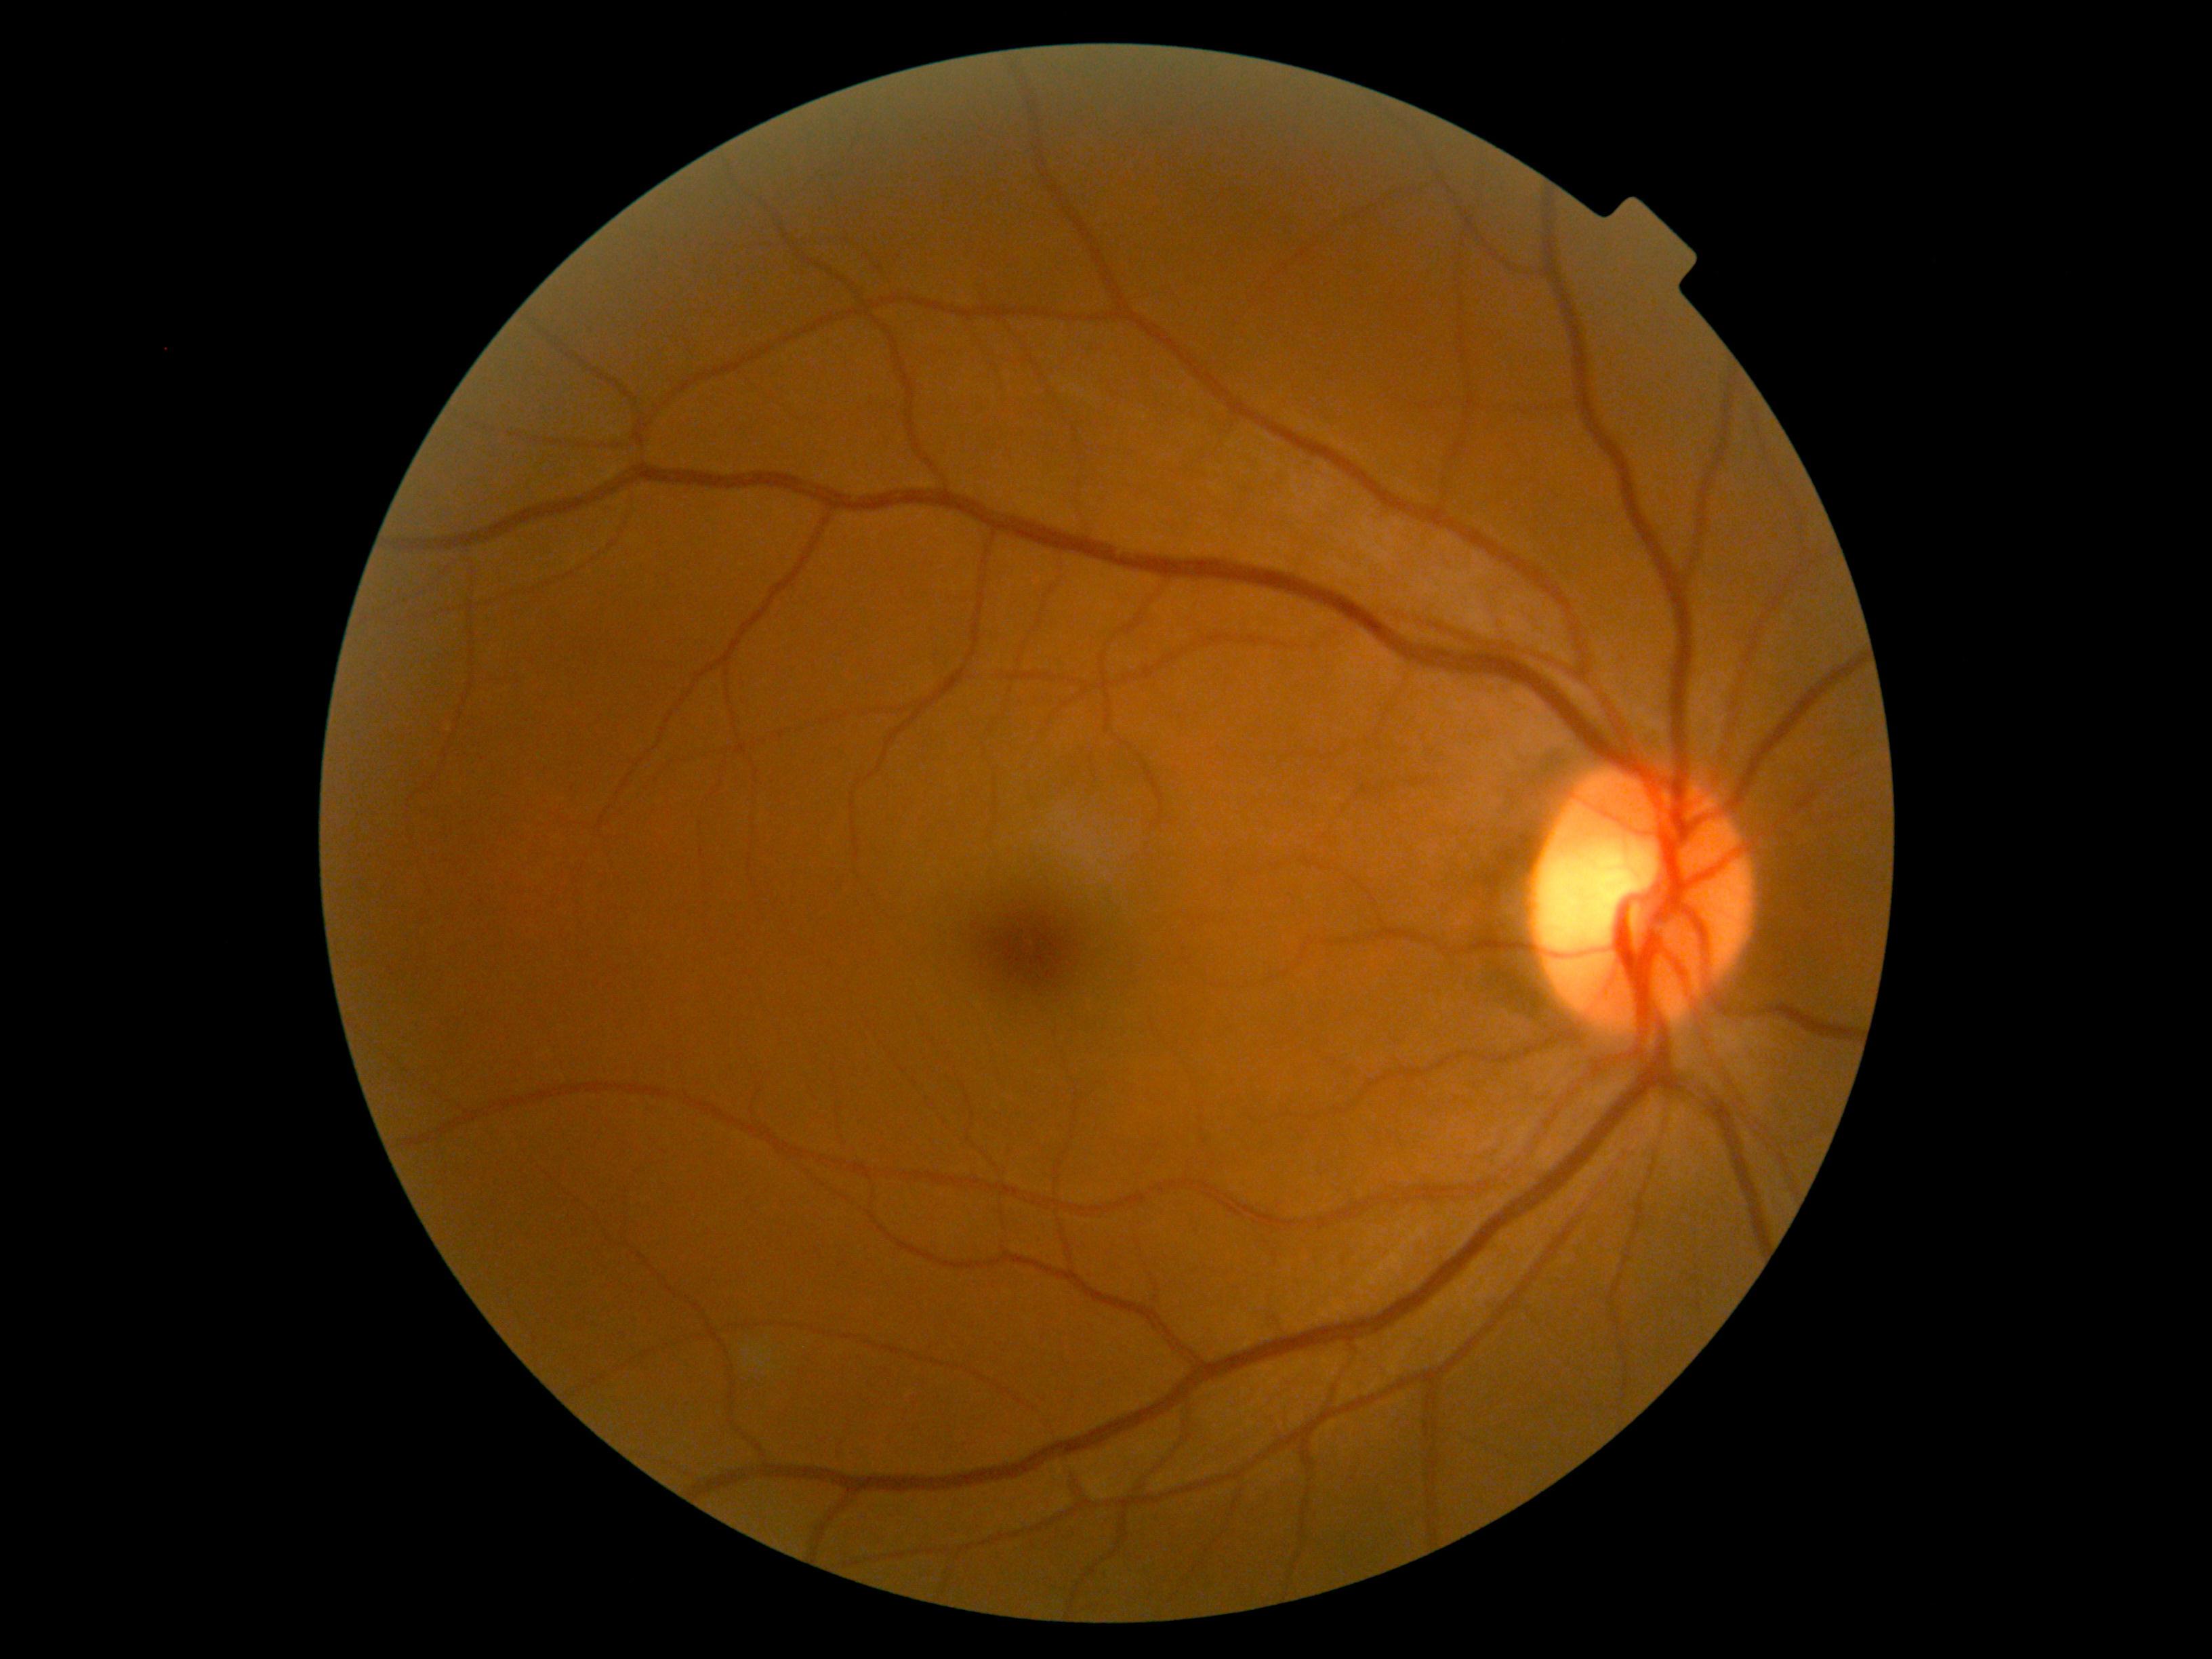
DR stage is 0.